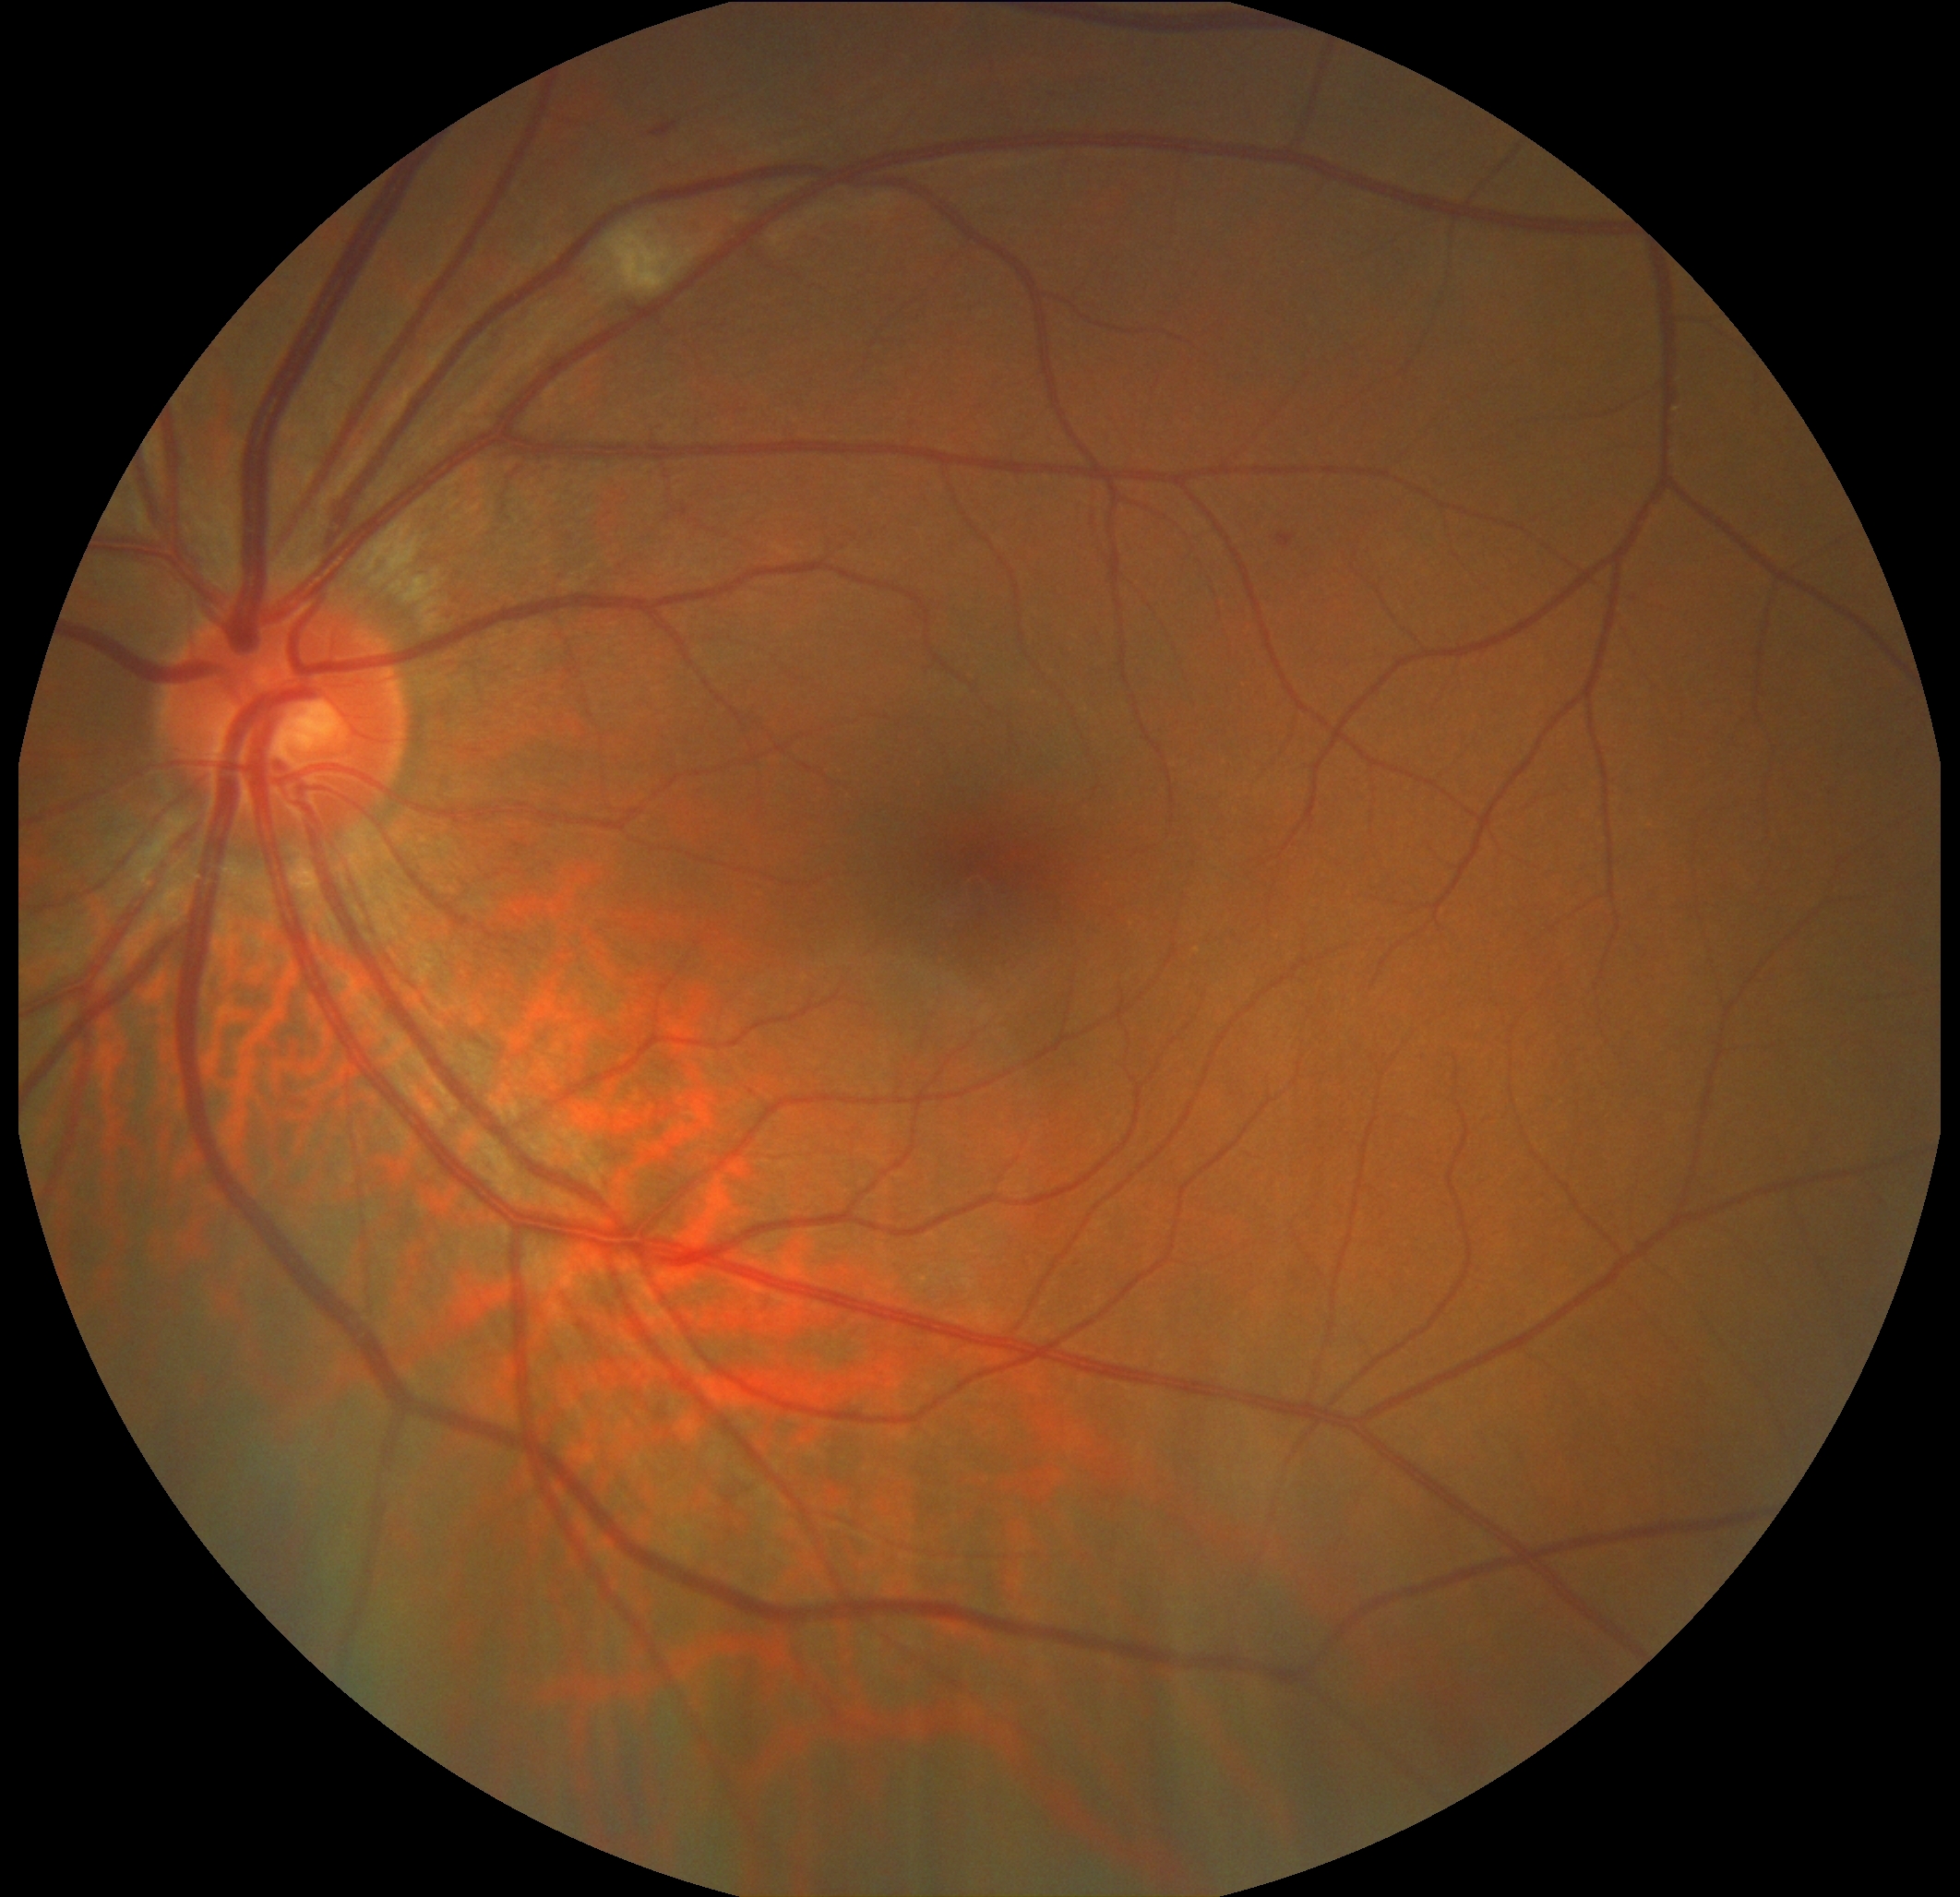

DR severity: 2/4.